45° field of view. Image size 2212x1659
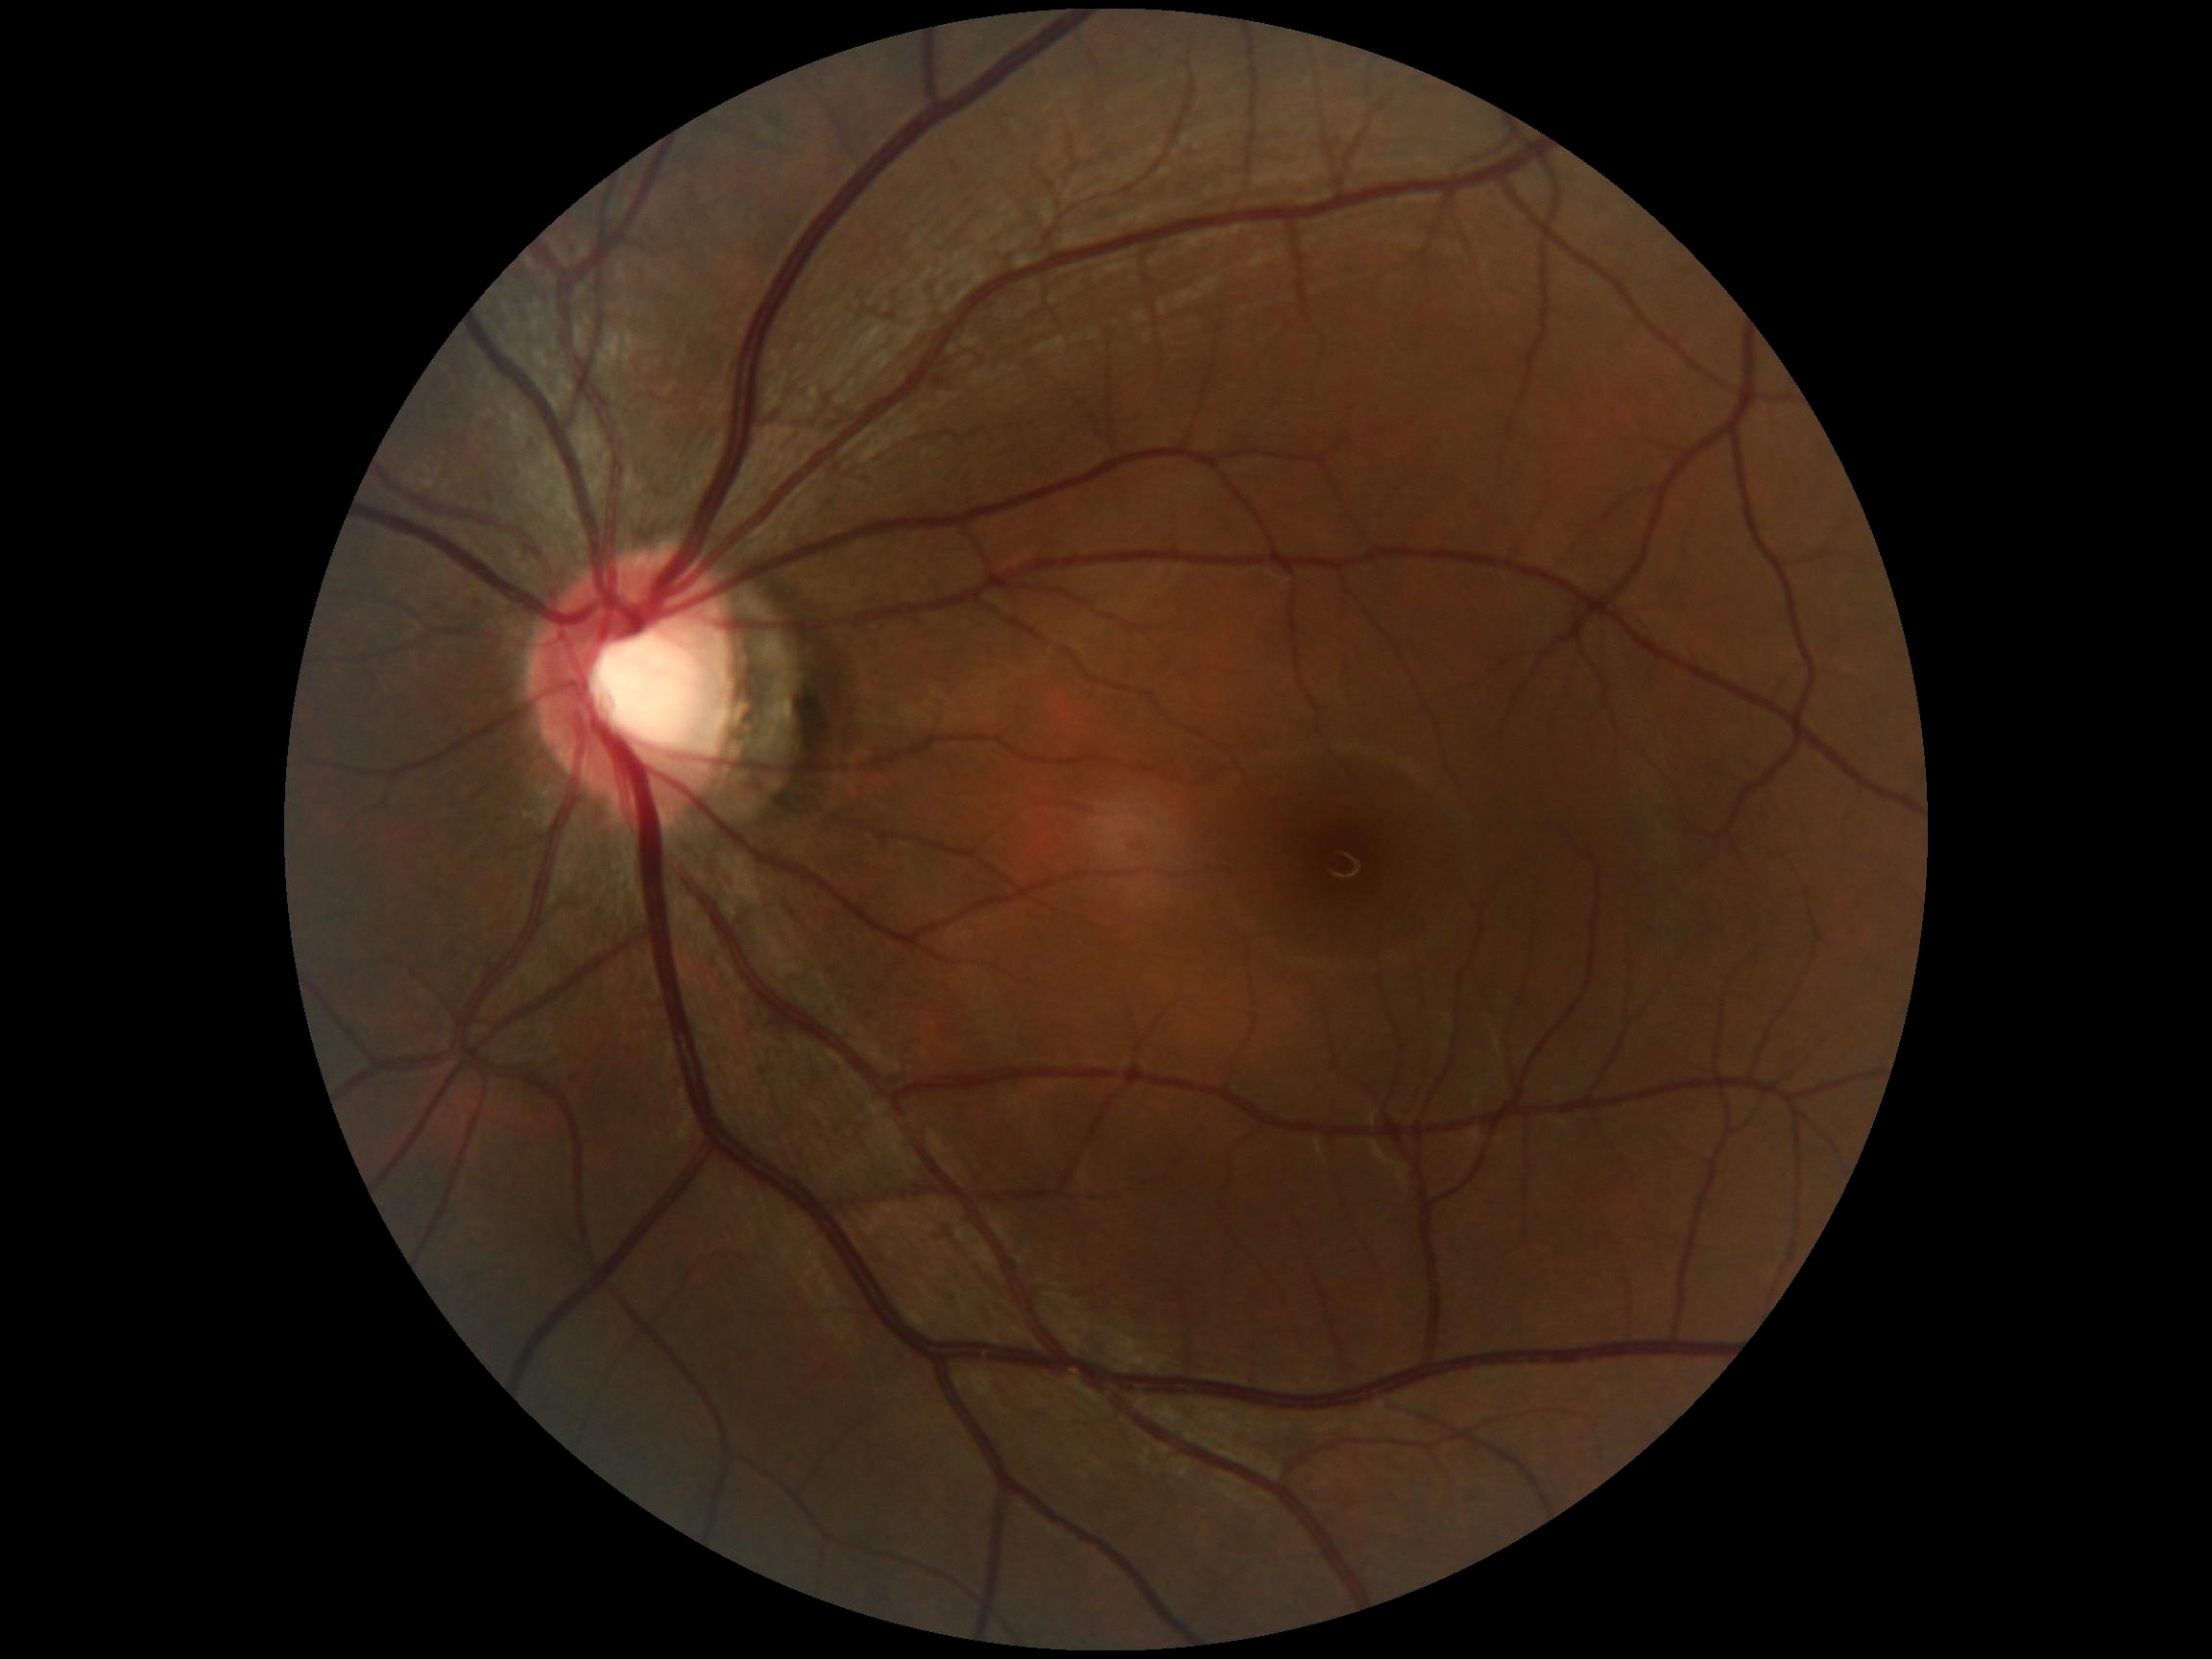 Findings:
– diabetic retinopathy (DR) — grade 0
– DR impression — no signs of DR